FOV: 45 degrees; image size 1960x1897:
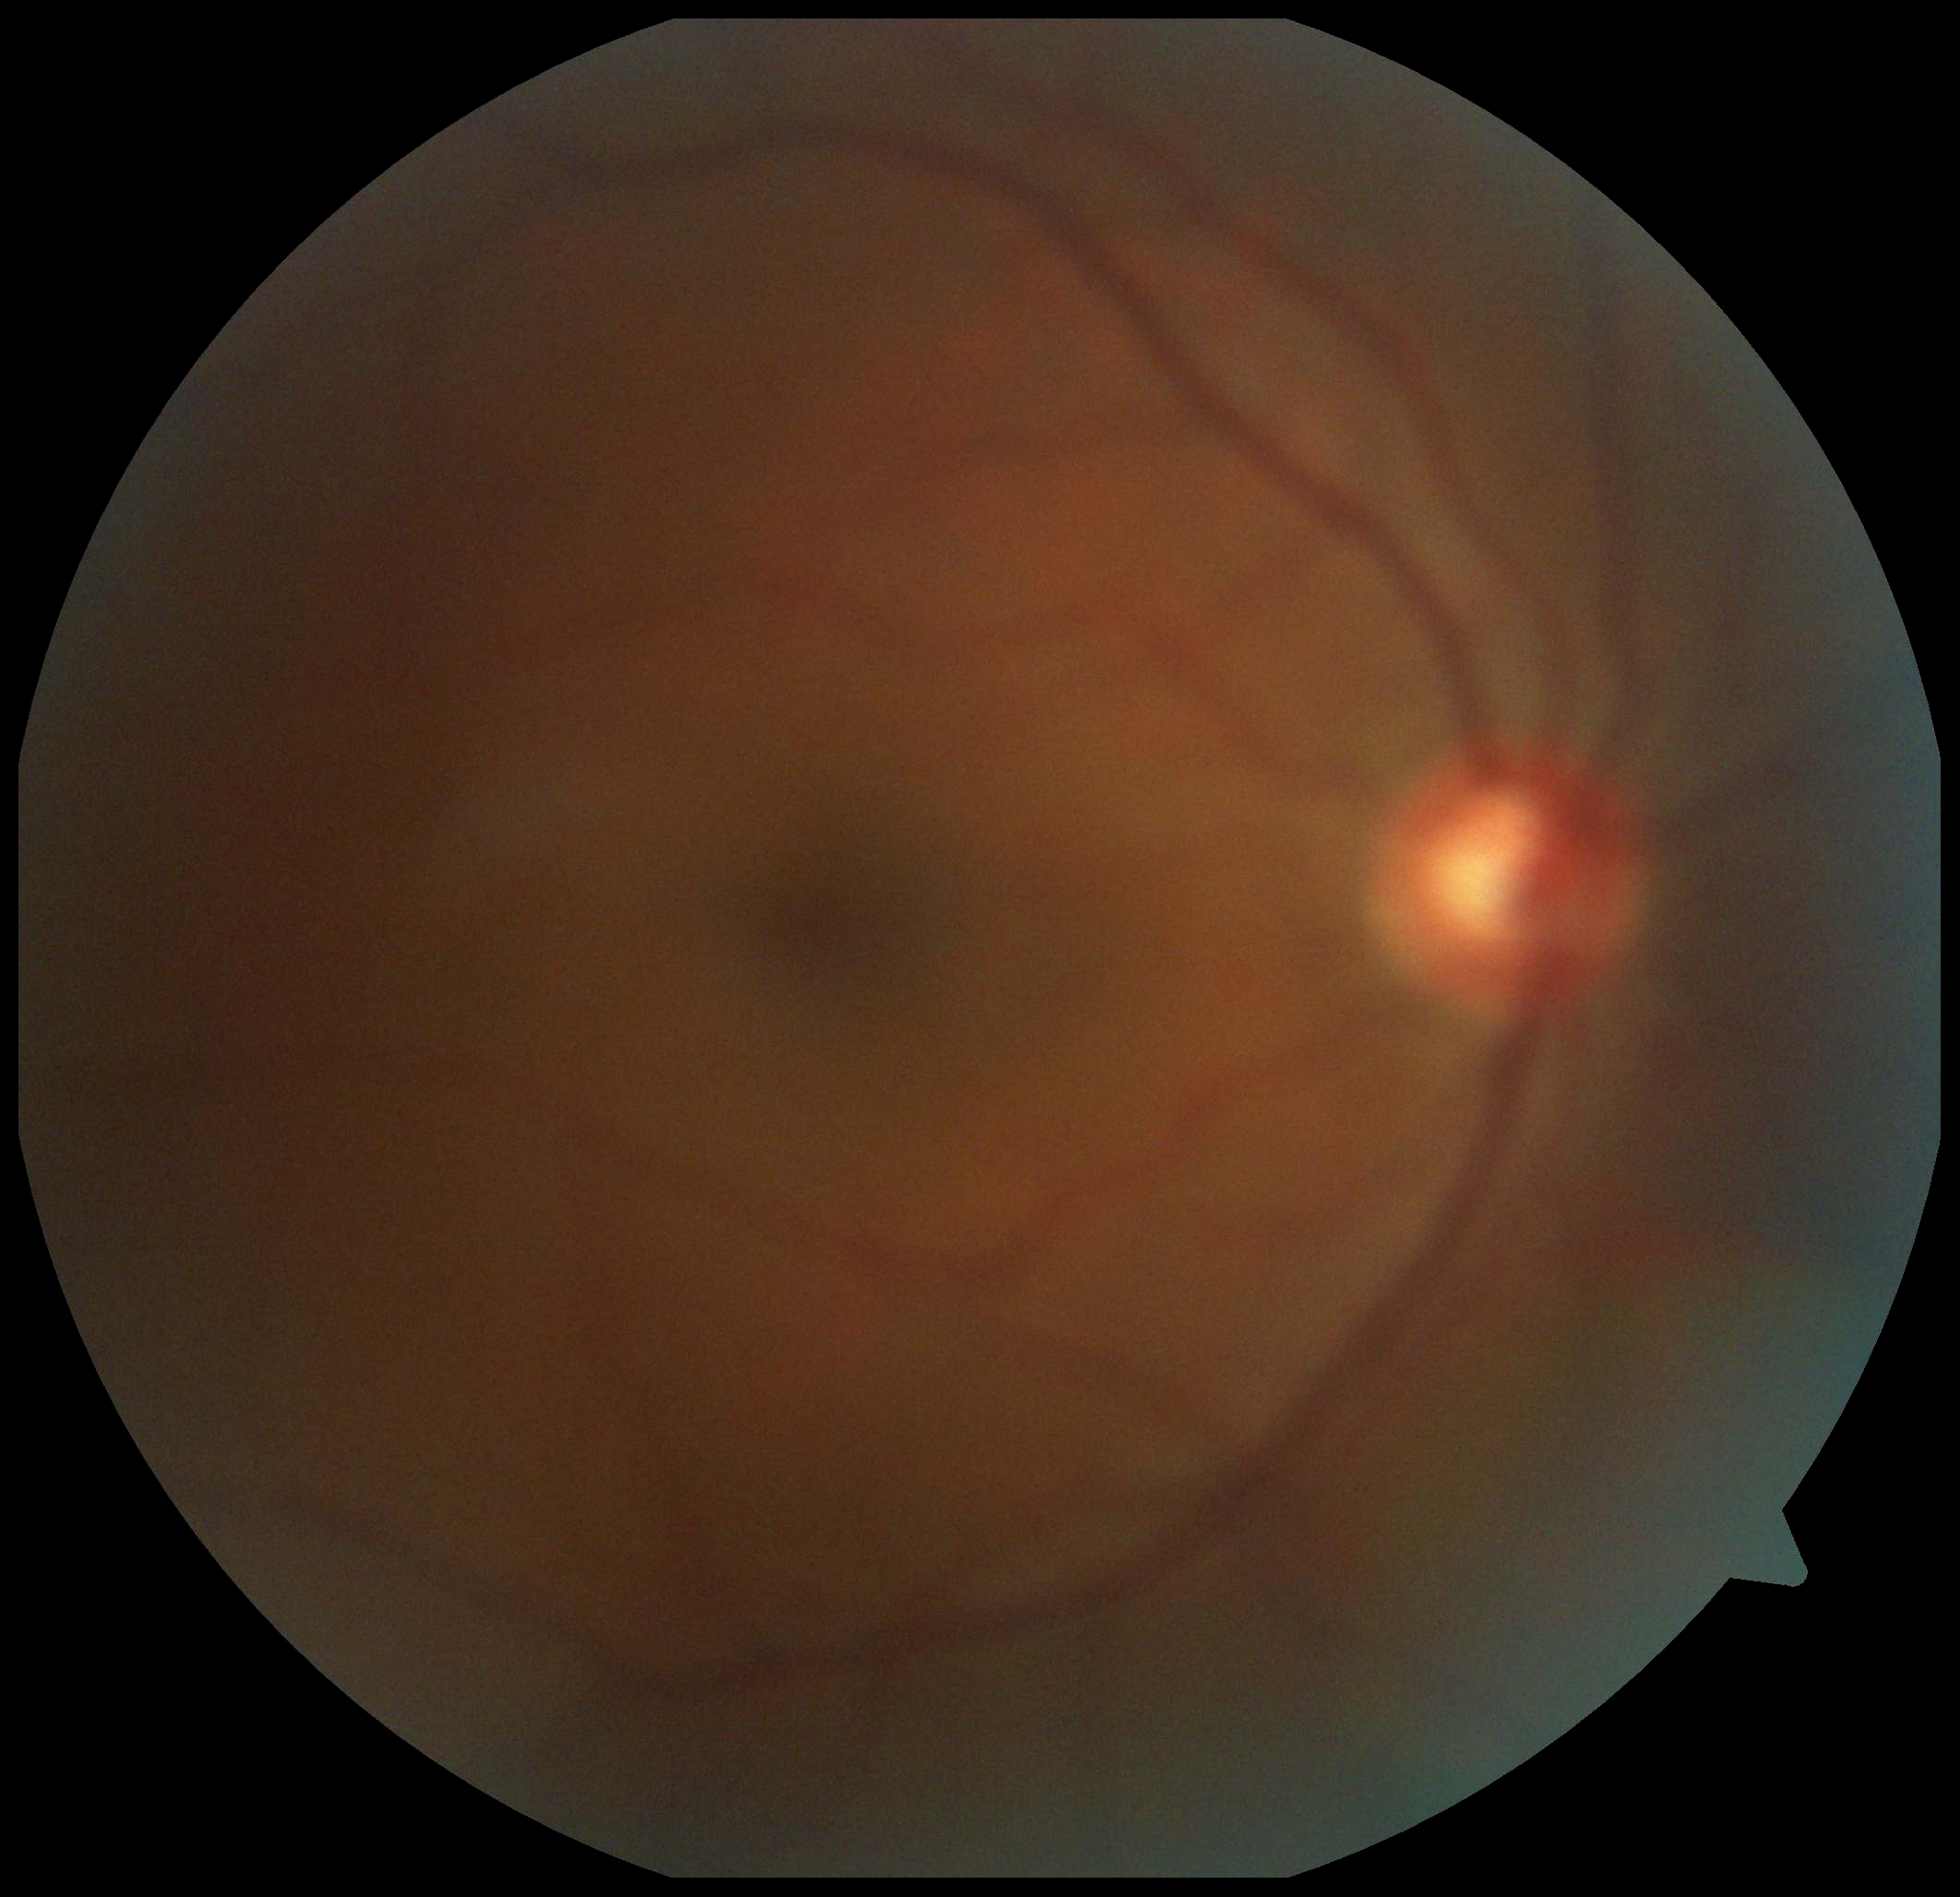 DR severity = 0/4 — no visible signs of diabetic retinopathy.